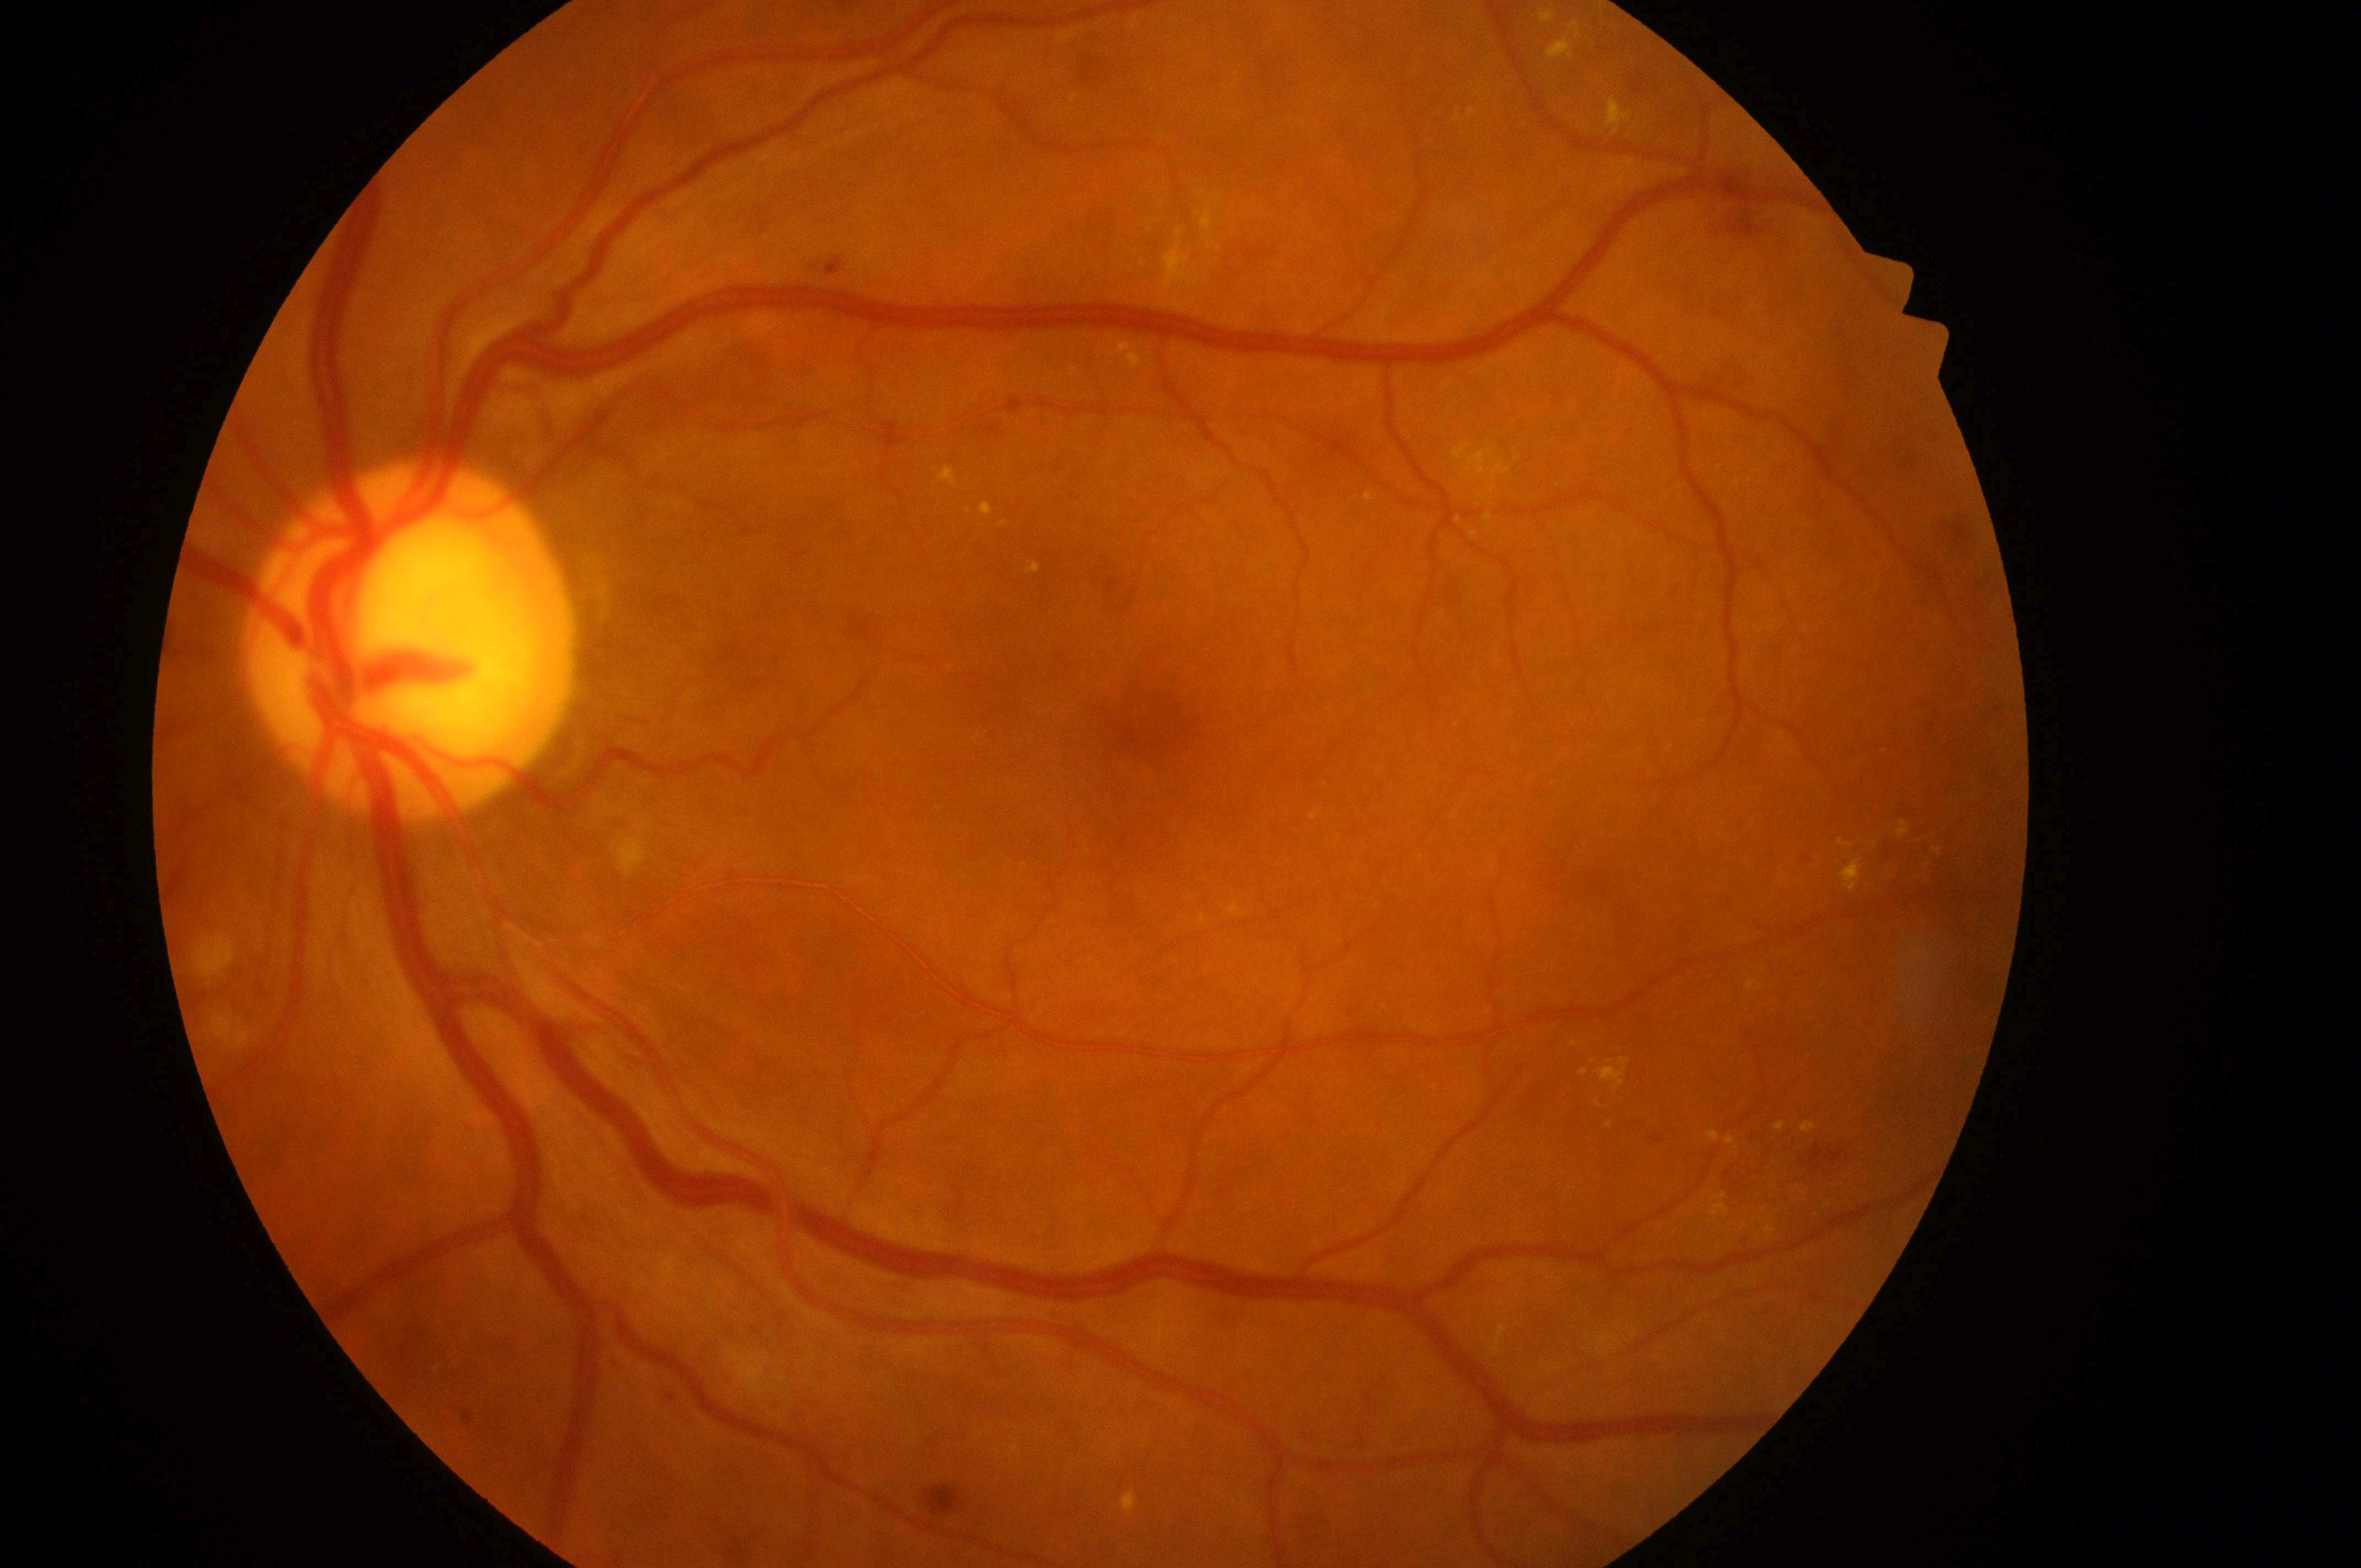 DR class: non-proliferative diabetic retinopathy.
Fovea center: (1147, 732).
DME is 2.
DR severity is 2.
Imaged eye: the left eye.
The optic disk is at (400, 651).